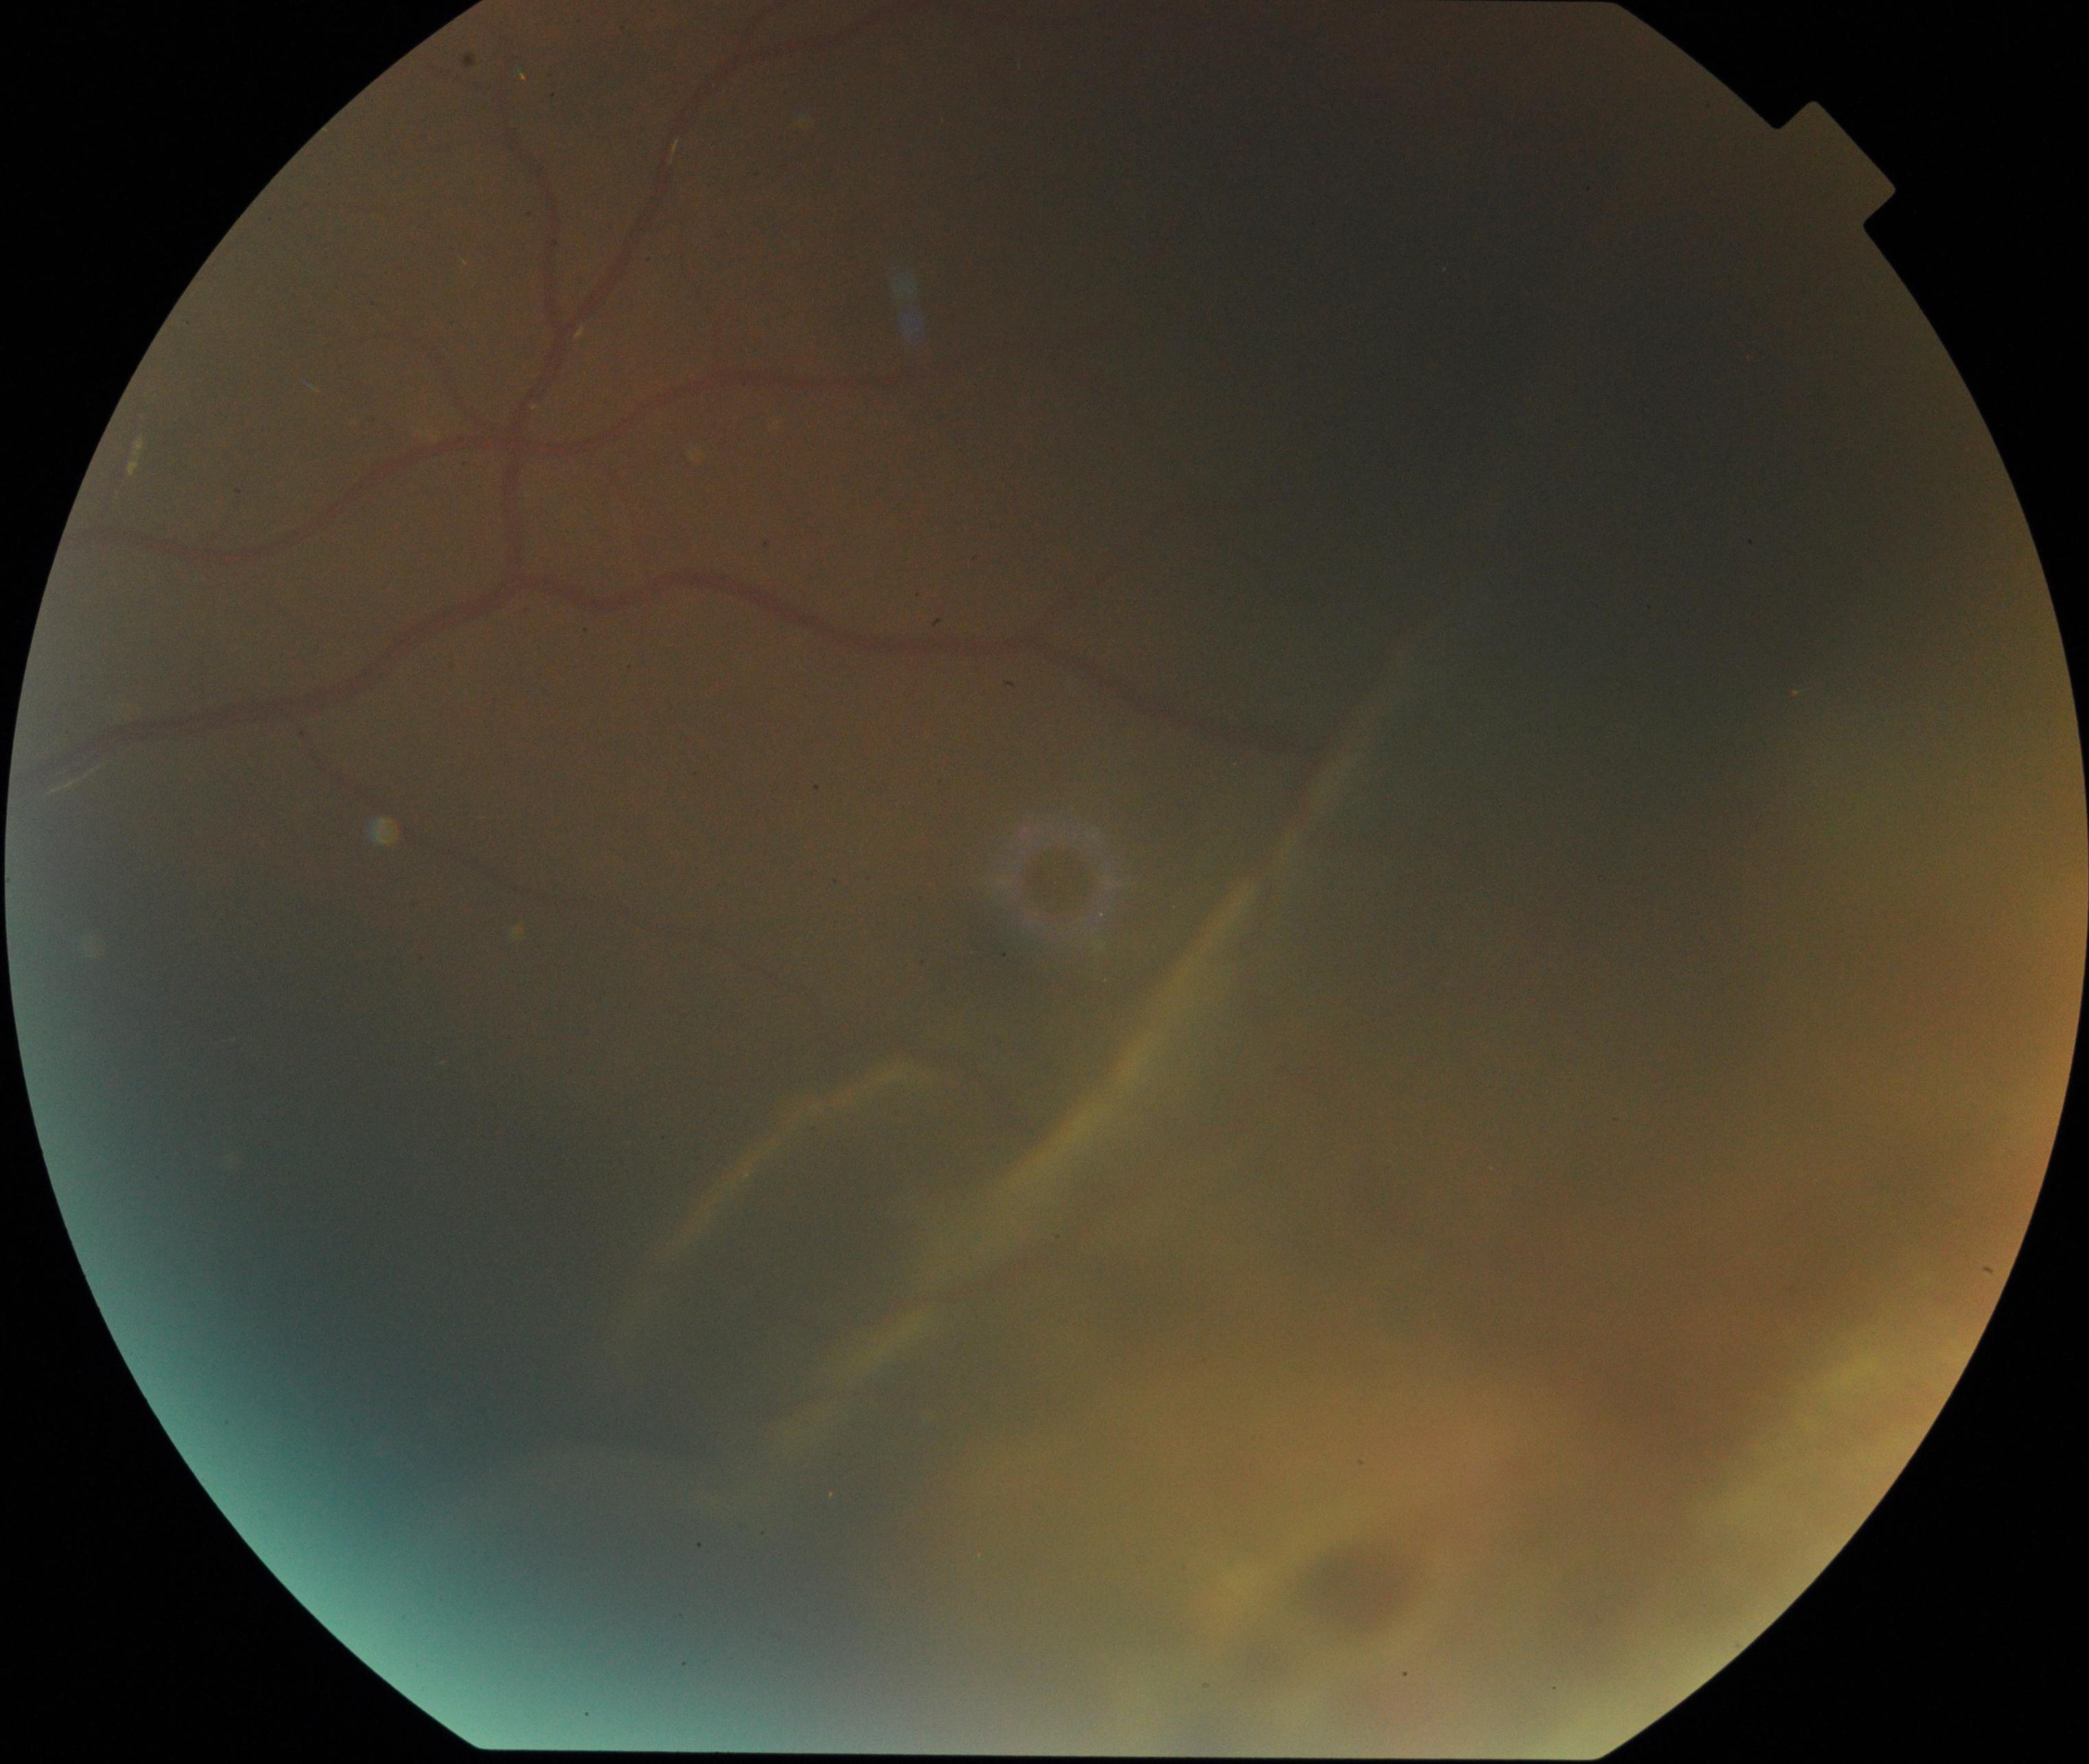
There is evidence of rhegmatogenous retinal detachment.